Pediatric retinal photograph (wide-field) · 1240 x 1240 pixels:
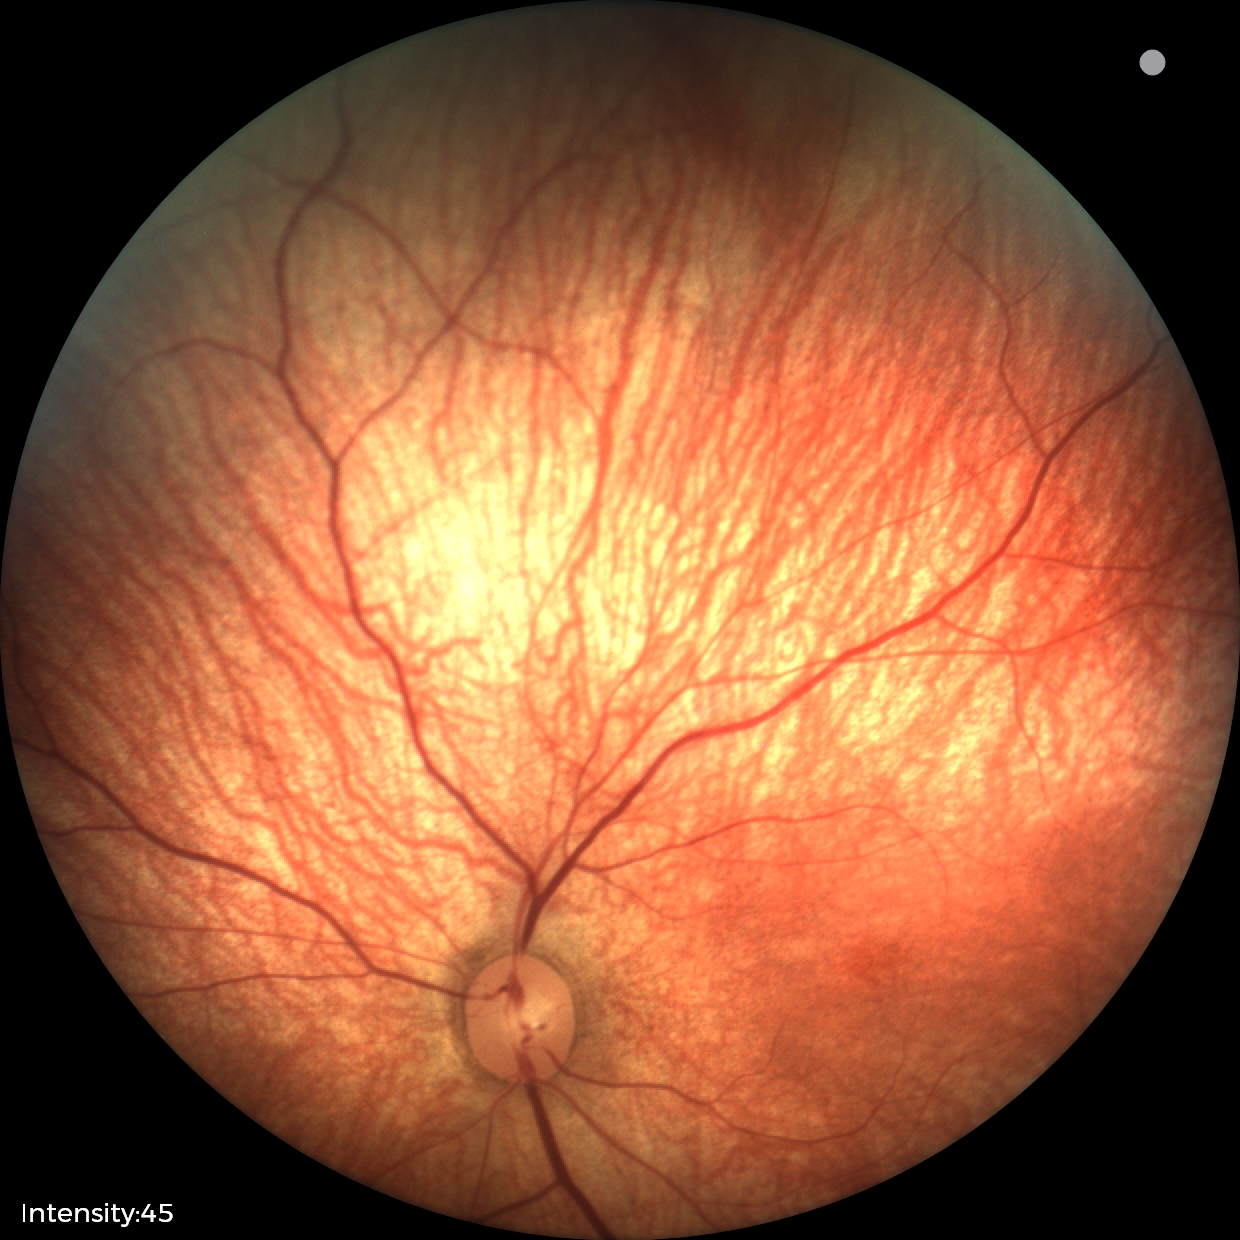 Examination with physiological retinal findings.